Image size 848x848 · NIDEK AFC-230 · graded on the modified Davis scale — 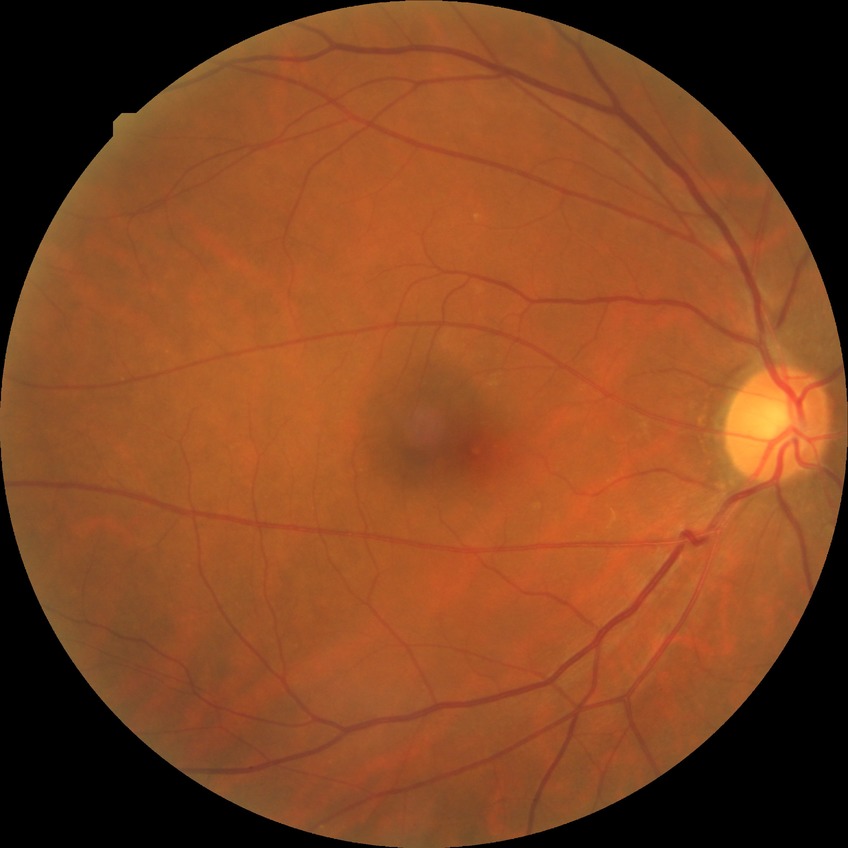
  davis_grade: no diabetic retinopathy (NDR)